Wide-field fundus photograph of an infant:
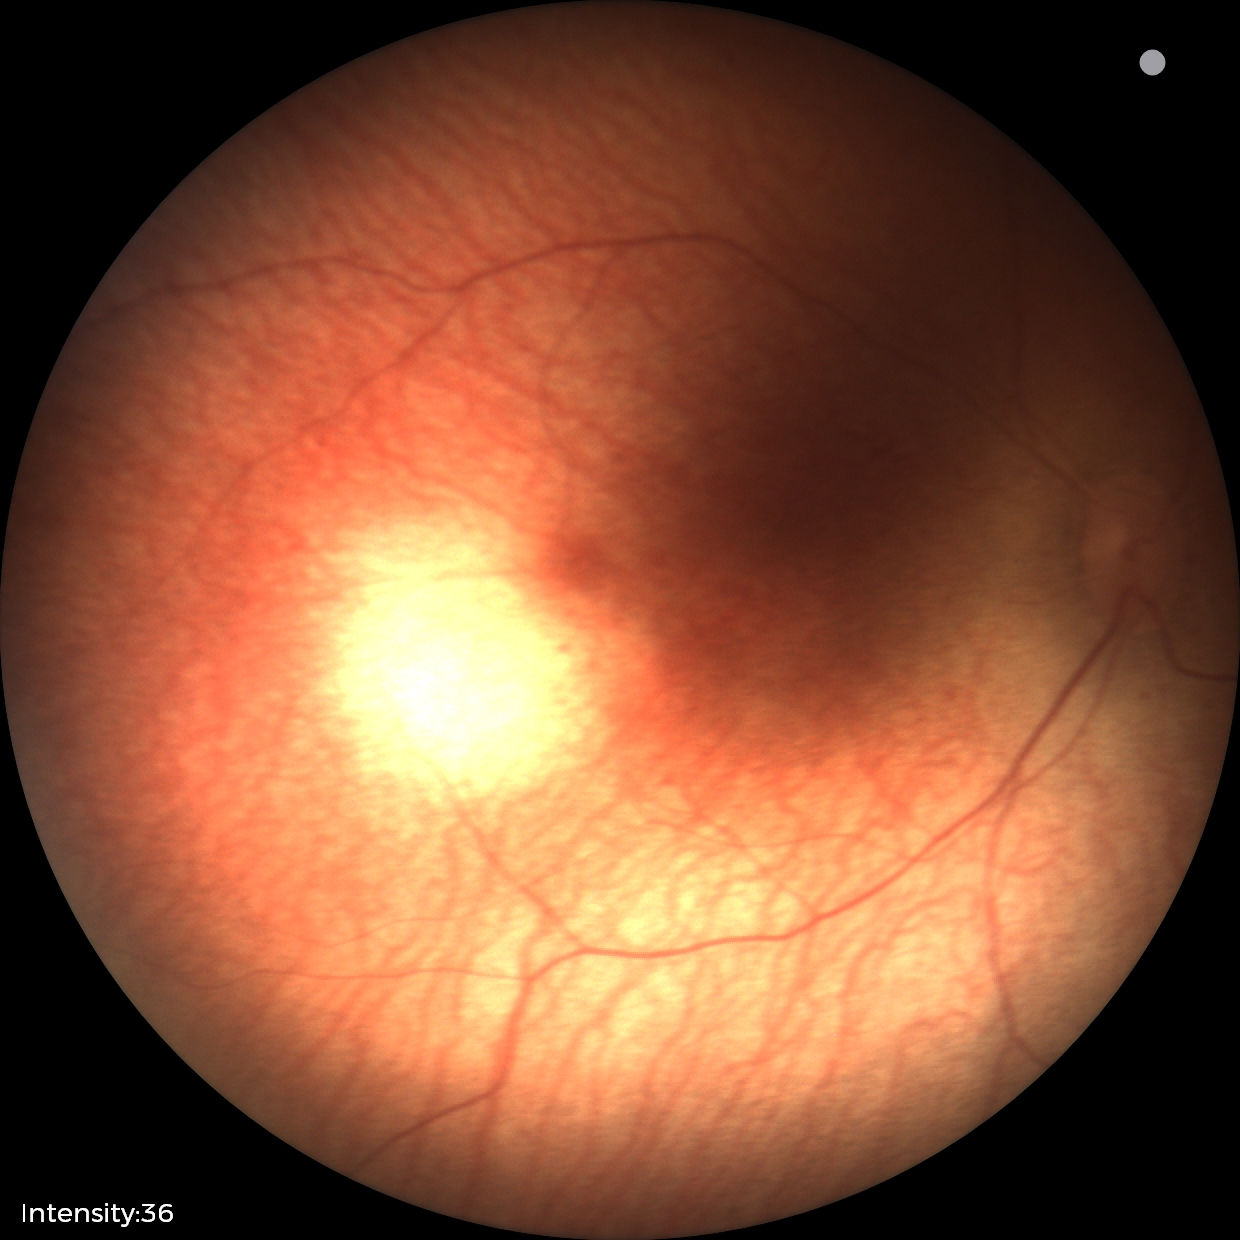
Physiological retinal appearance for postconceptual age.